45 degree fundus photograph.
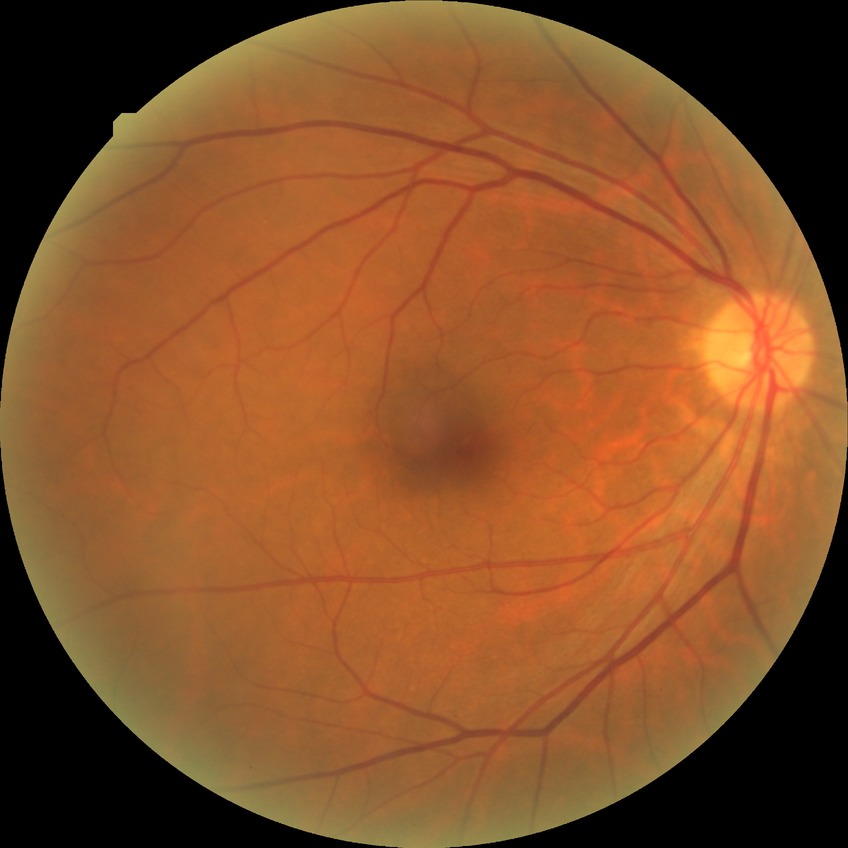

retinopathy stage: no diabetic retinopathy.